1240 by 1240 pixels. Infant wide-field retinal image
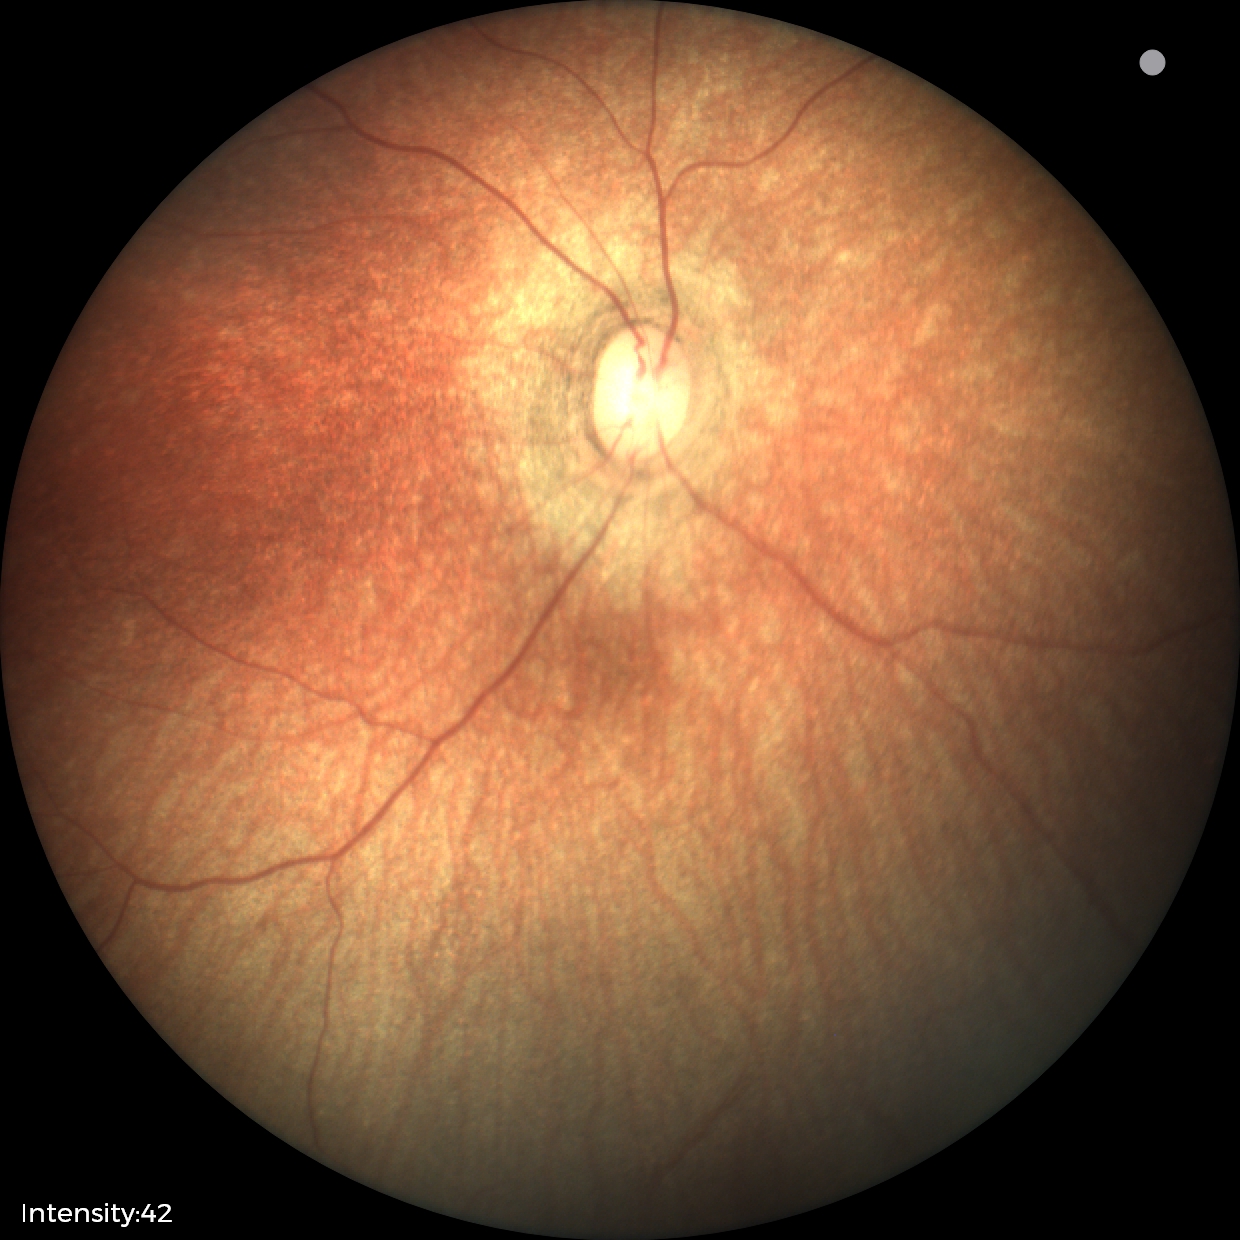

Q: What was the screening finding?
A: physiological appearance with no retinal pathology